UWF retinal mosaic: 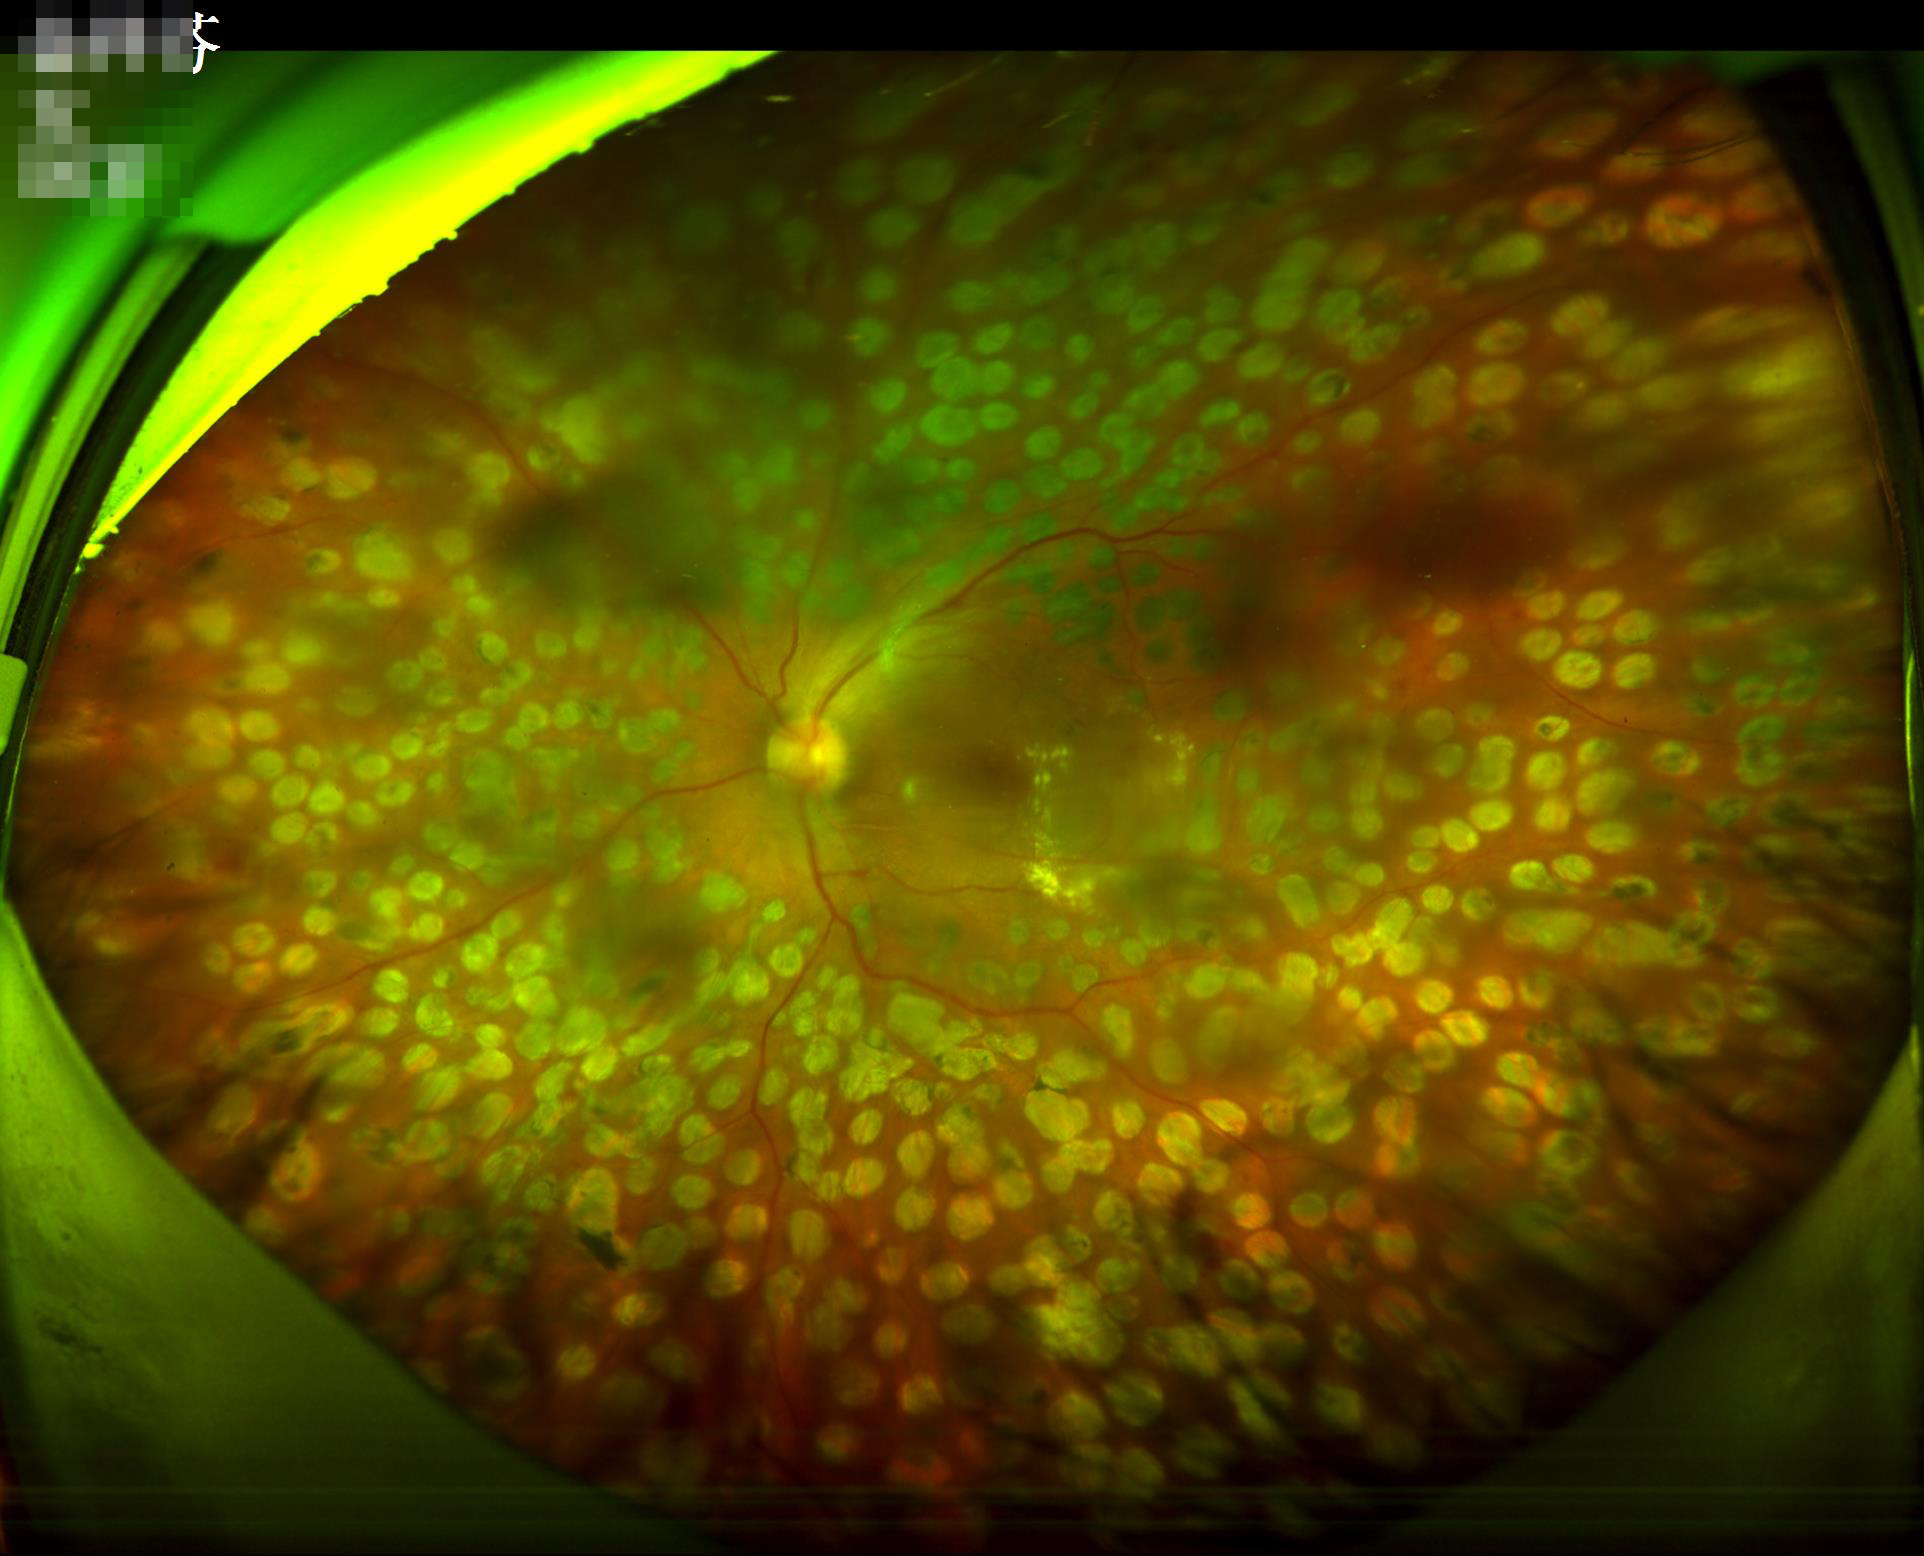 Quality grading:
- illumination: even
- overall: poor
- contrast: satisfactory
- sharpness: blurry